Color fundus image — 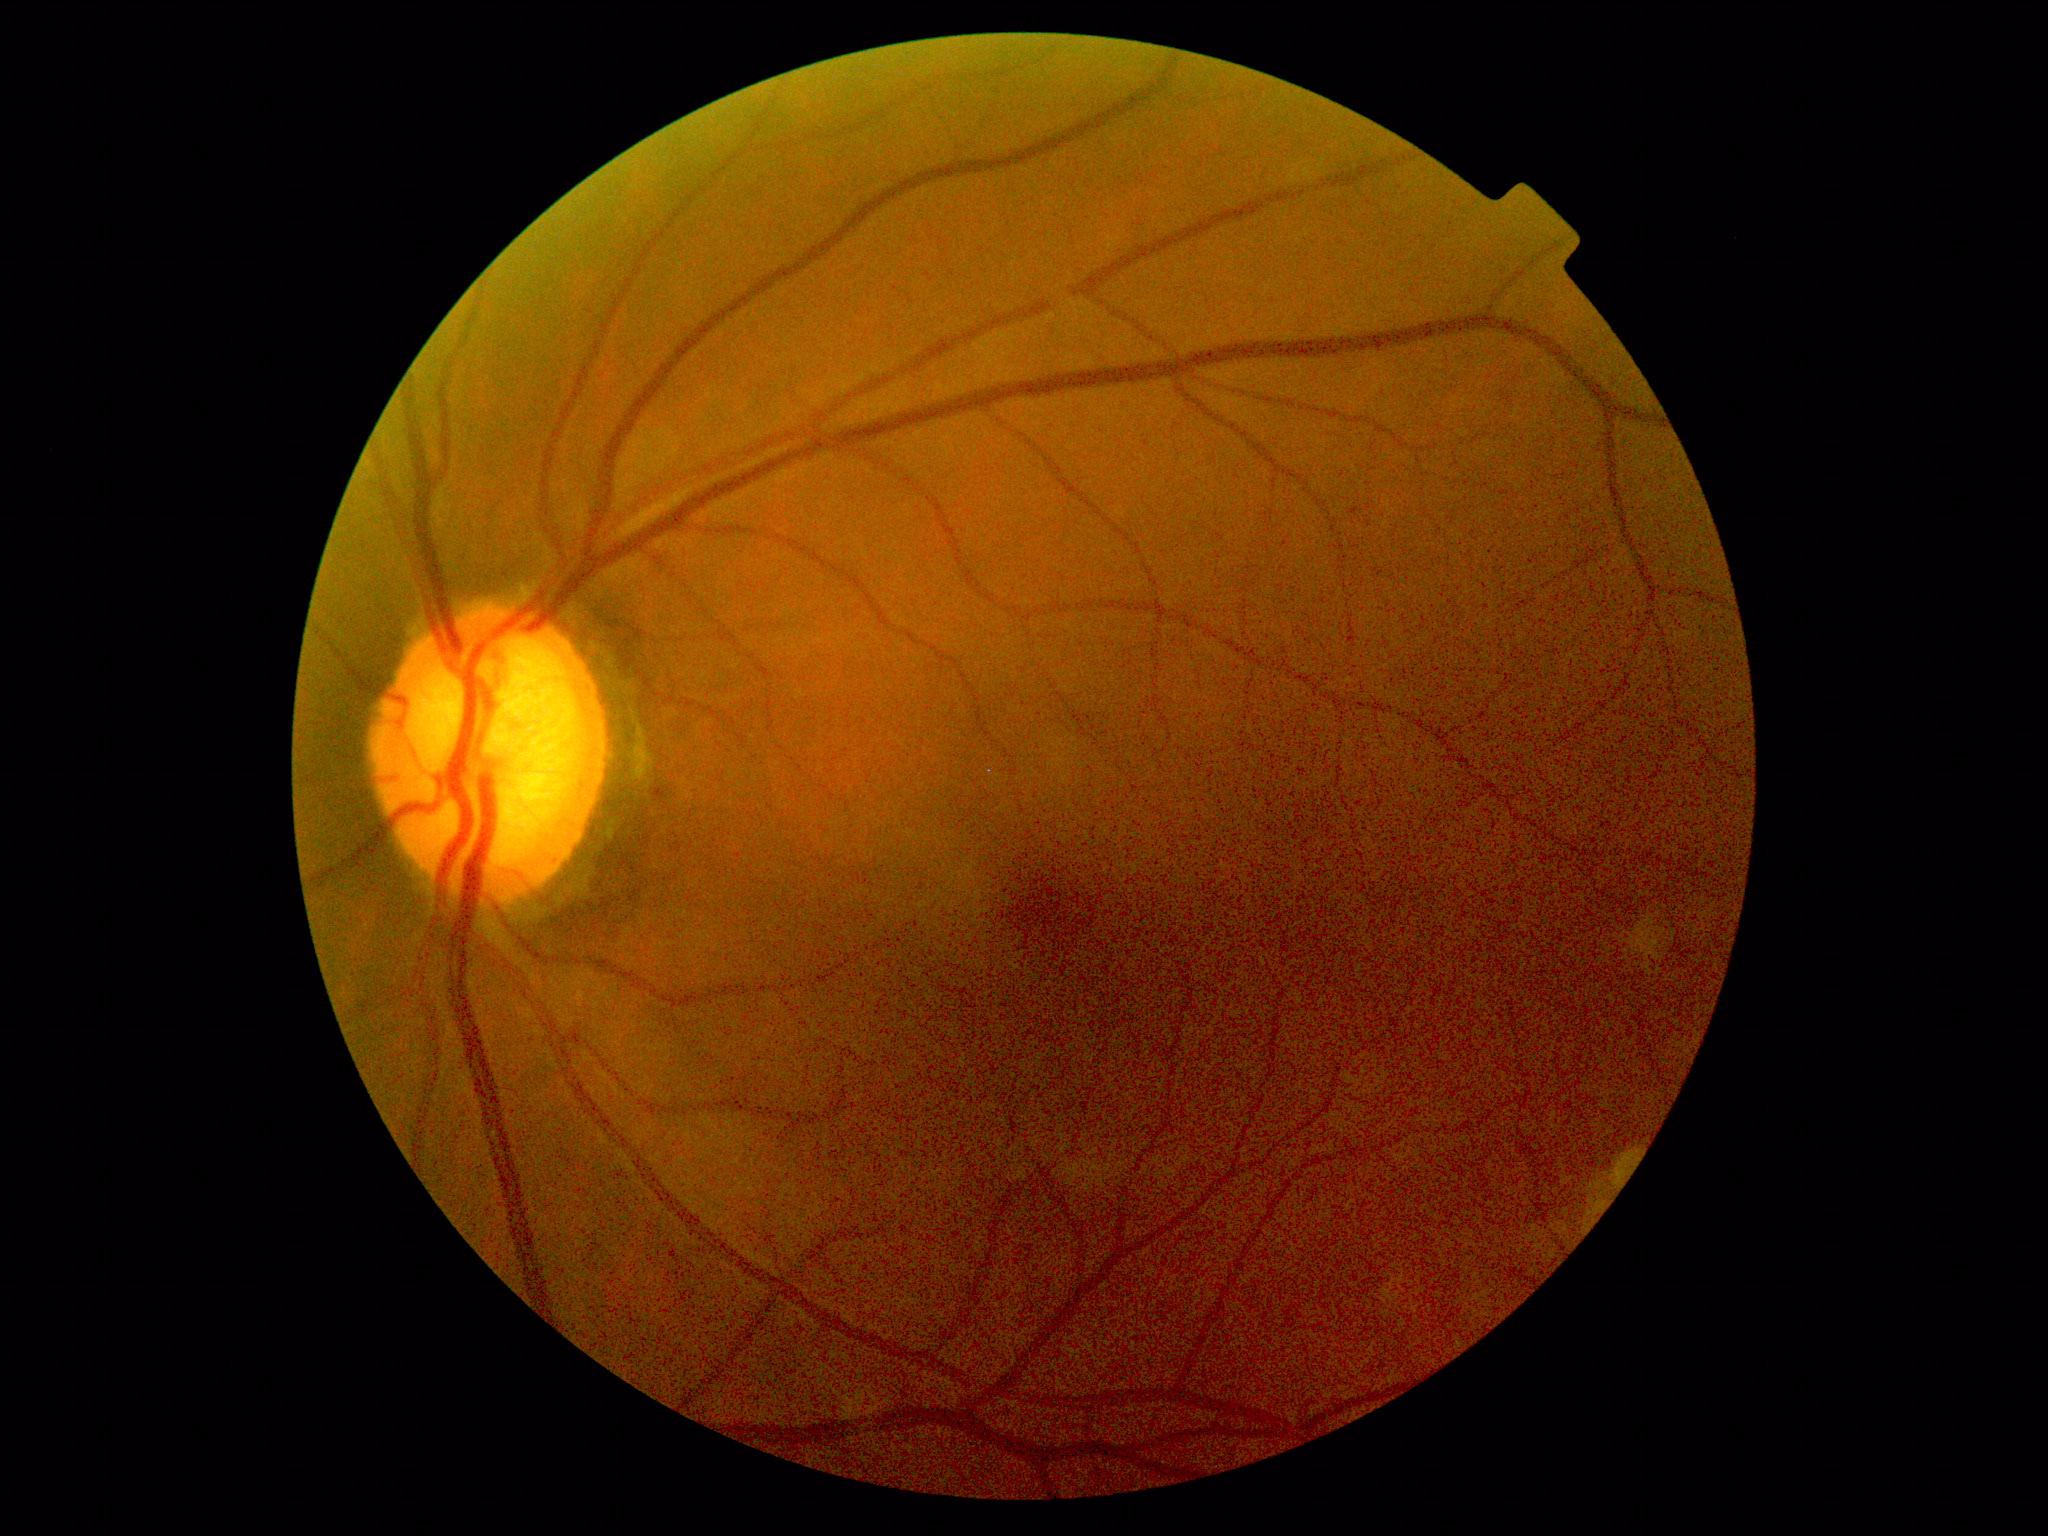 Retinopathy grade is 0/4.